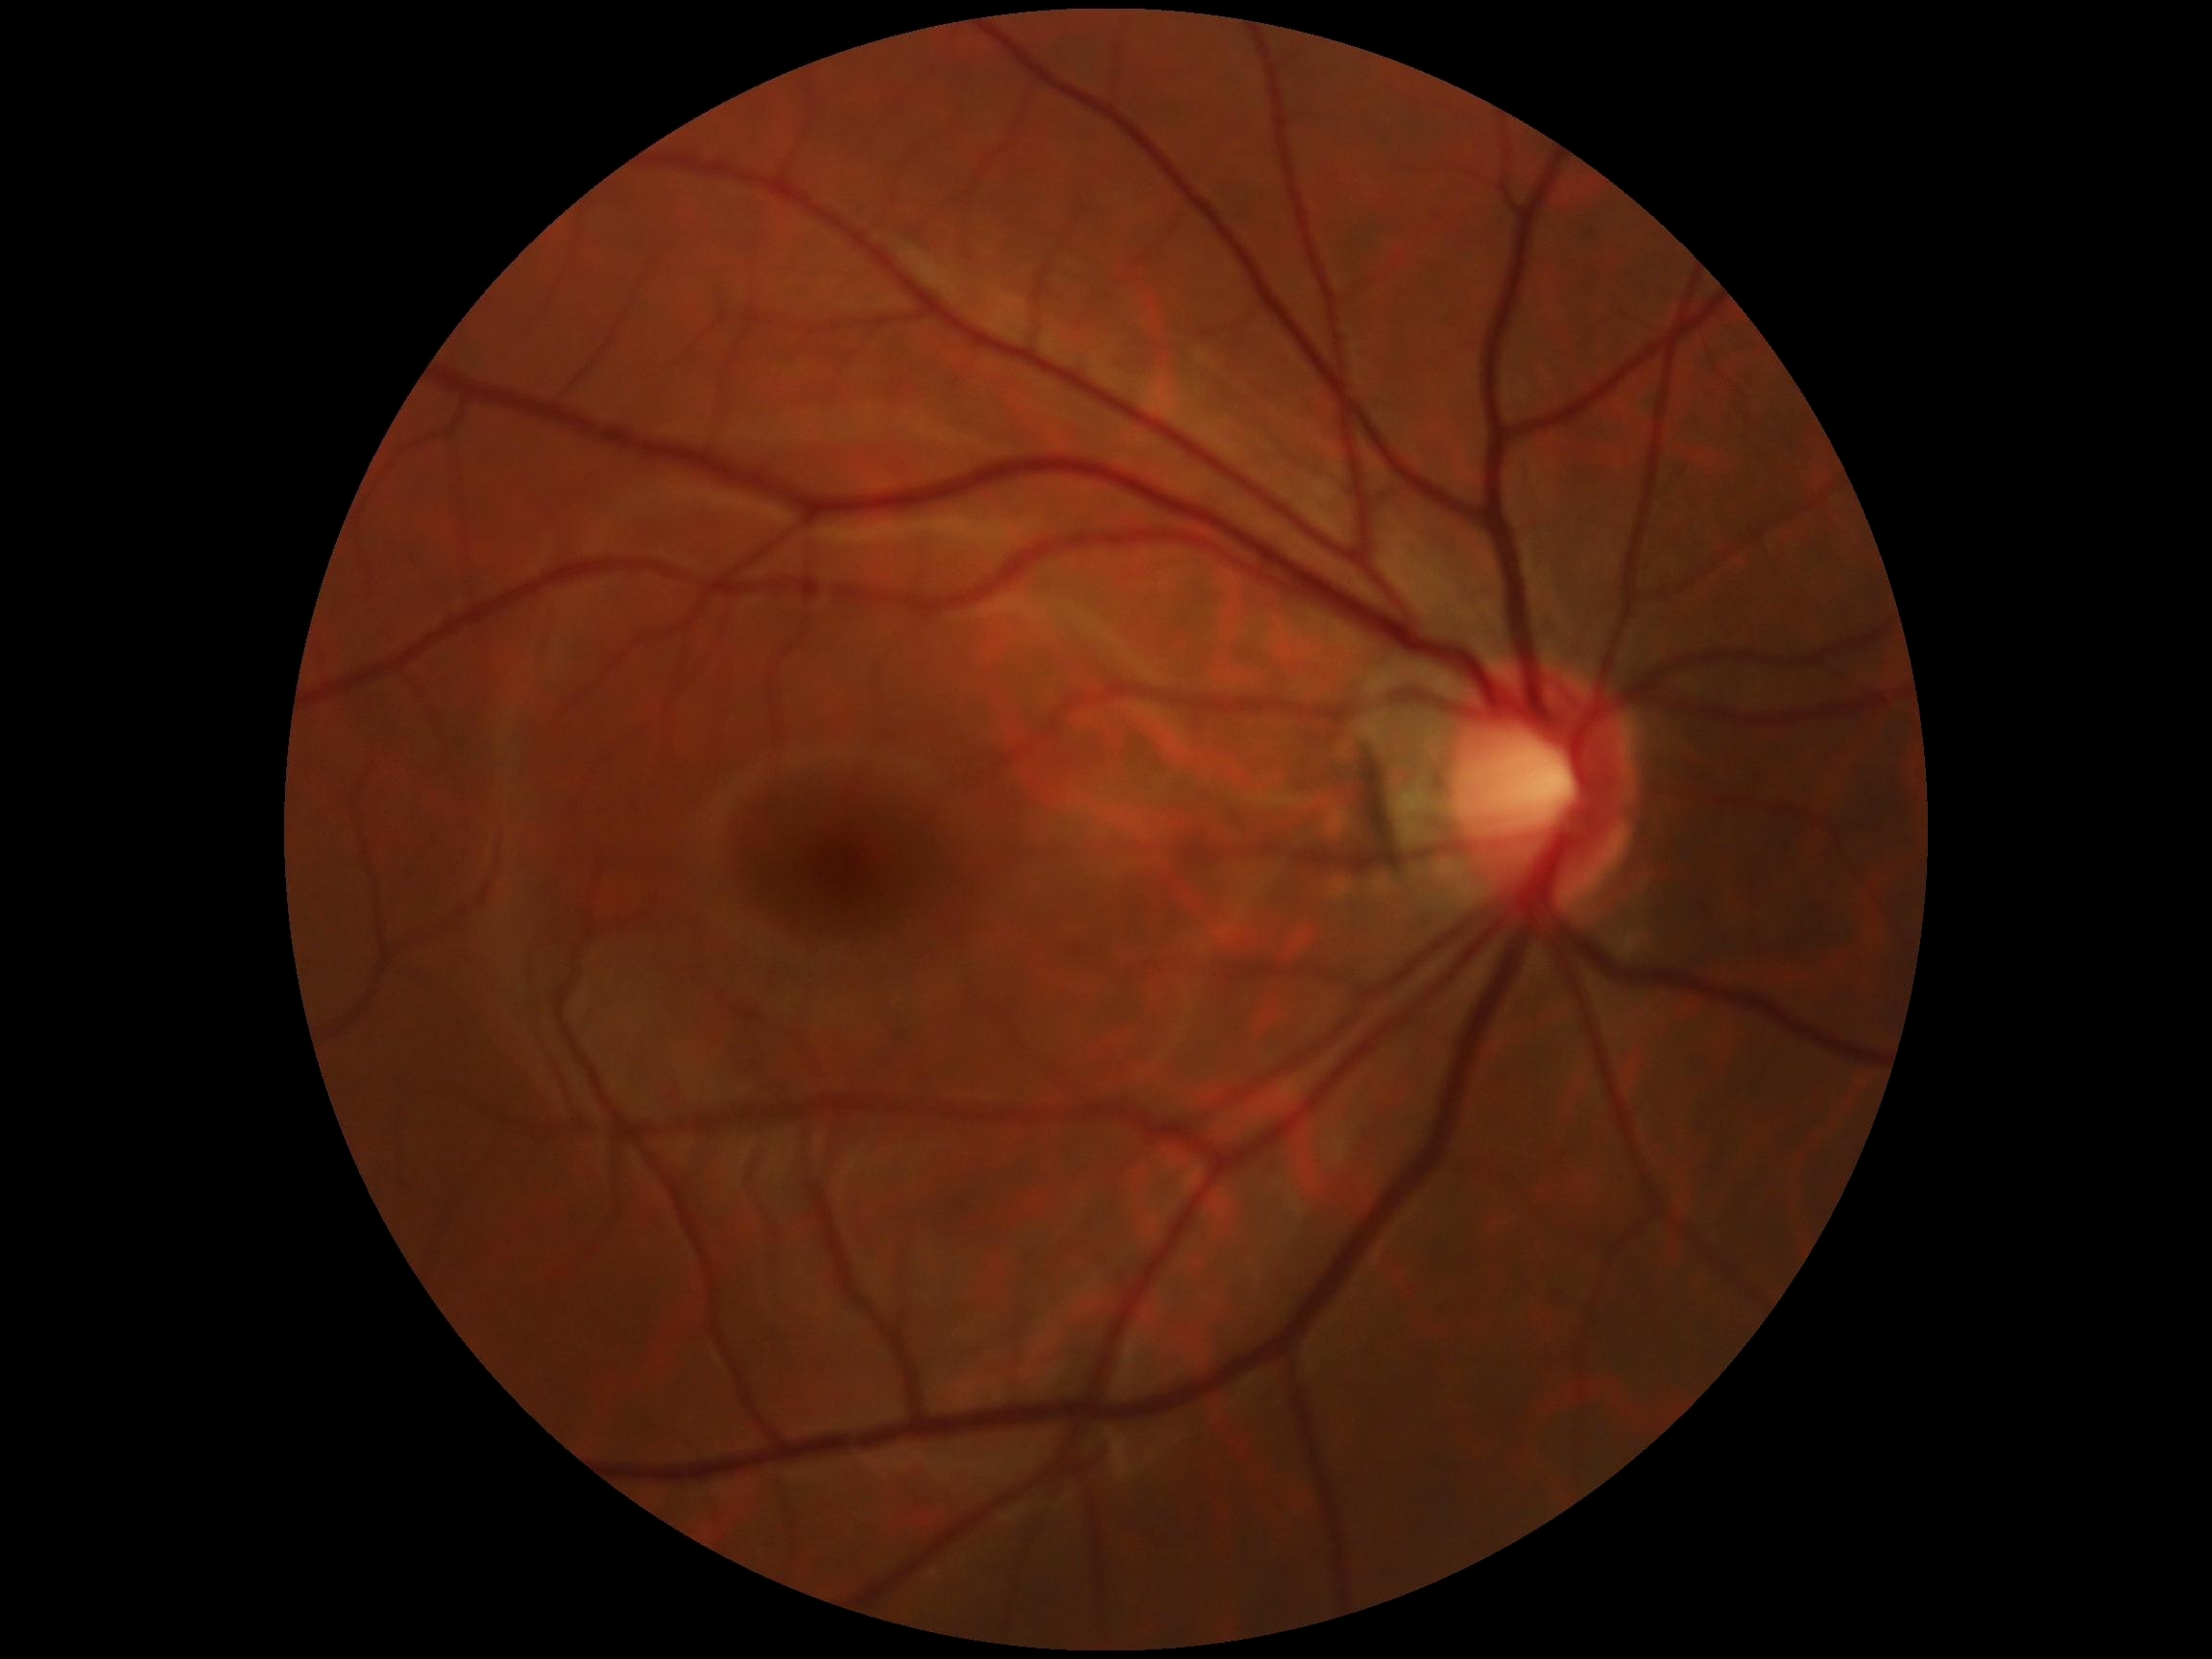 Diabetic retinopathy (DR): 0 — no visible signs of diabetic retinopathy.